Color fundus image — 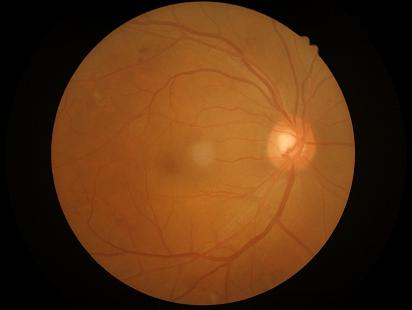
Acceptable image quality.
Even illumination with no color cast.
Good dynamic range.
Image is sharp throughout the field.